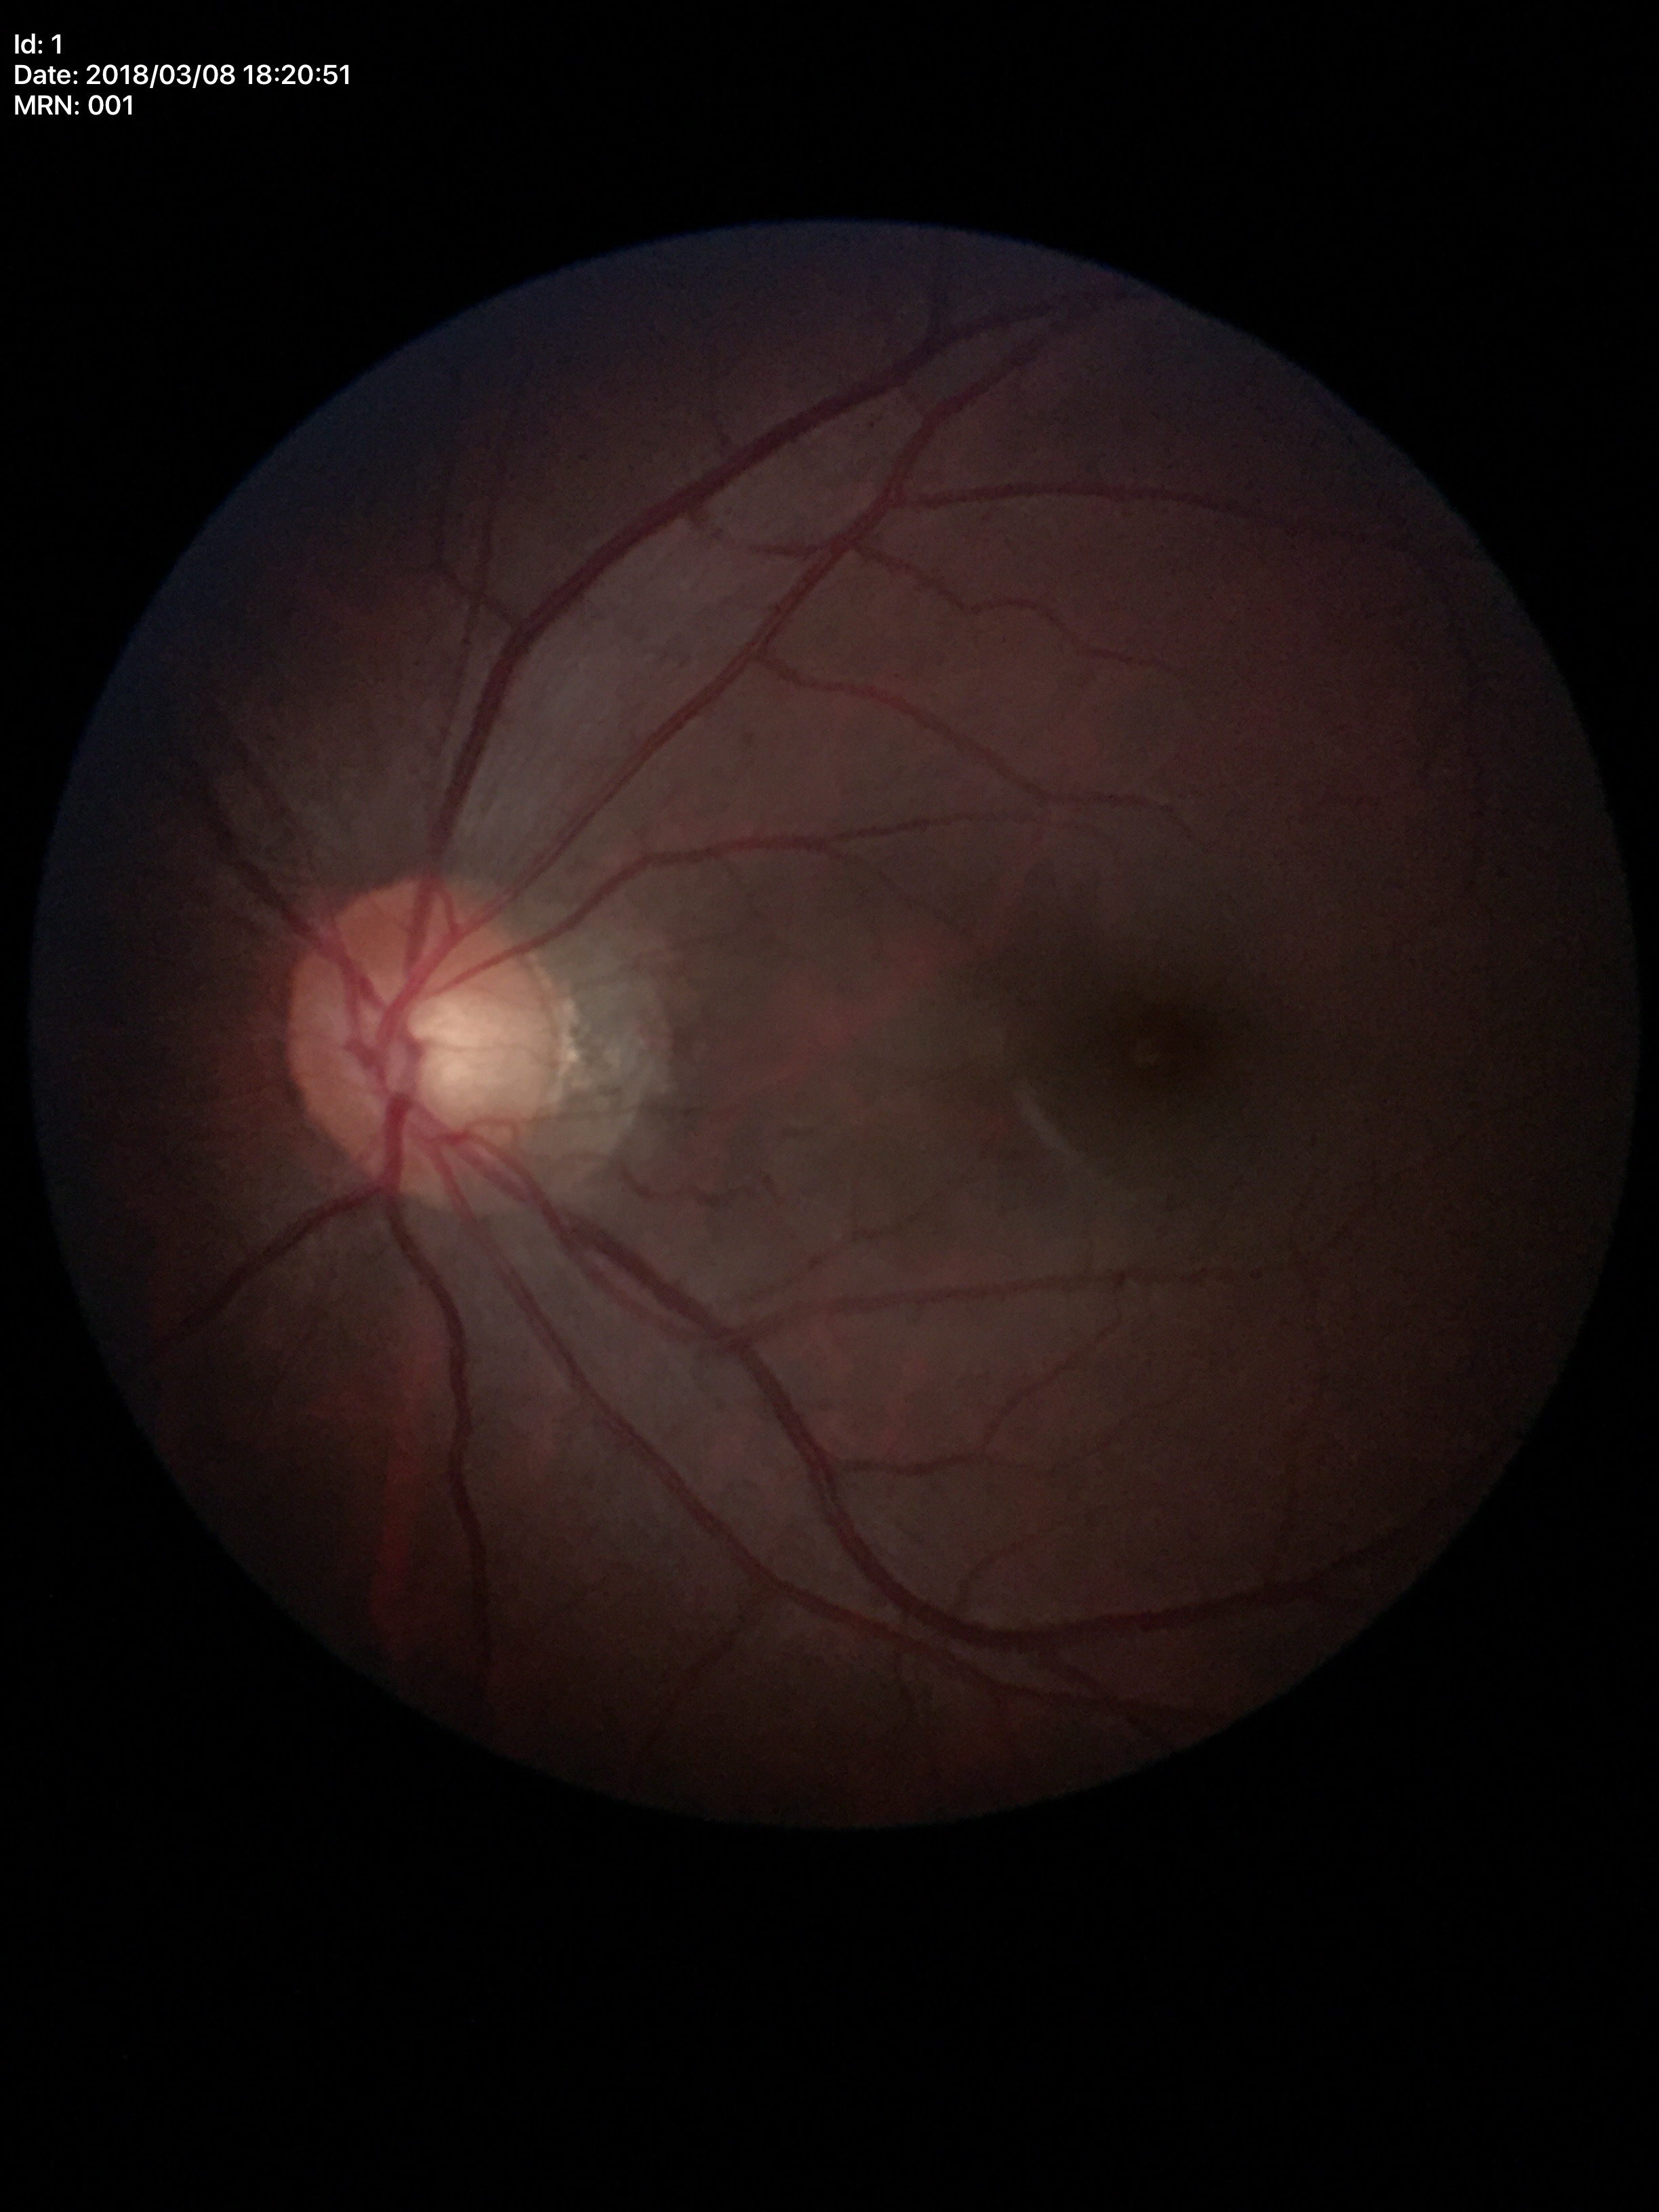

  glaucoma_decision: not suspect (all 5 graders called normal)
  vcdr: 0.48